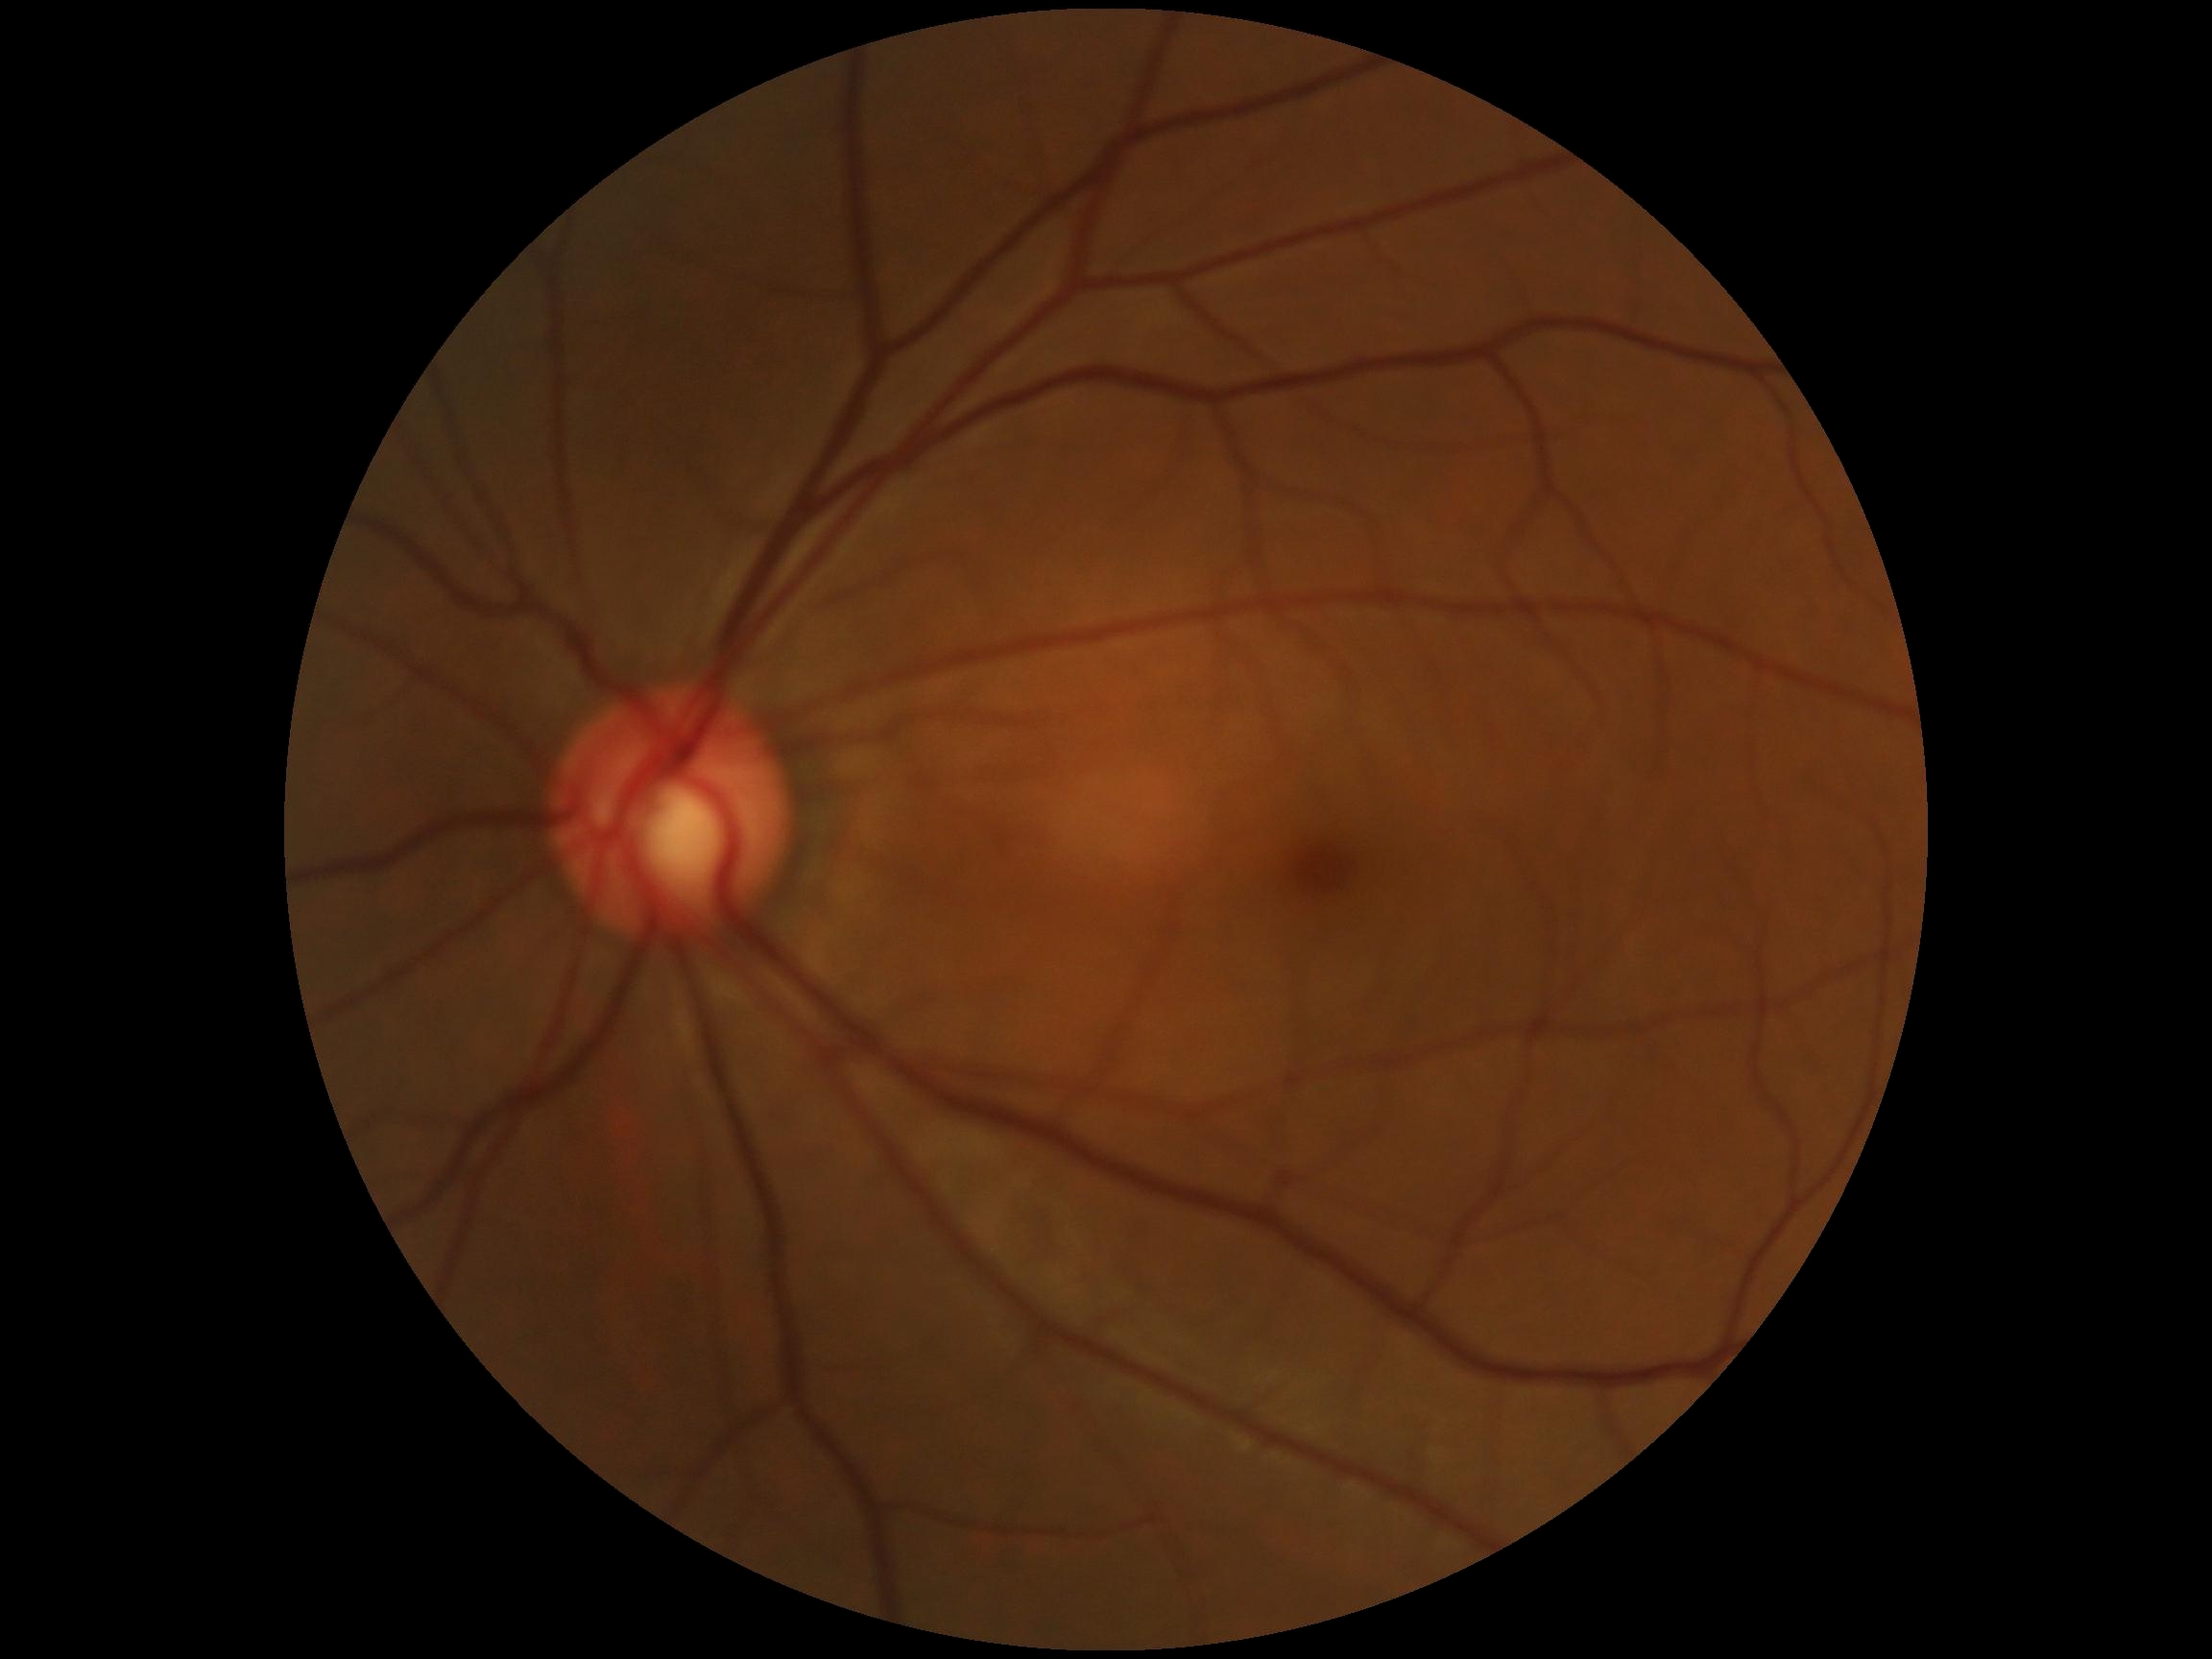 No signs of diabetic retinopathy. Retinopathy grade: no apparent retinopathy (0).